Image size 1240x1240; wide-field contact fundus photograph of an infant — 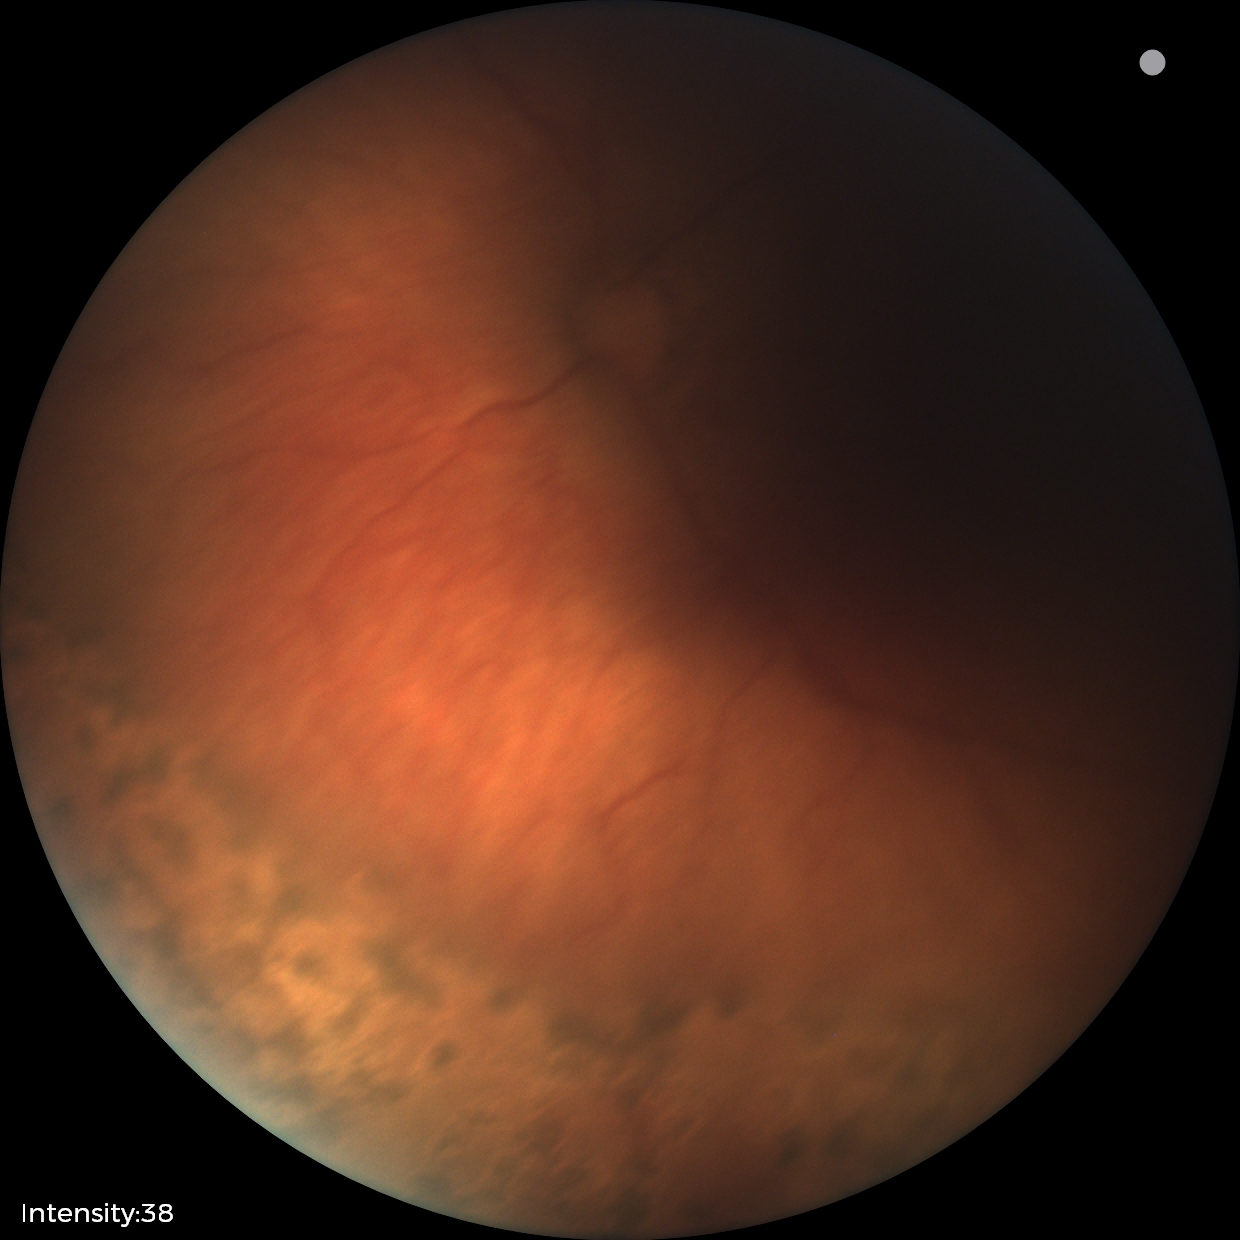
Q: What was the screening finding?
A: status post retinopathy of prematurity (ROP) — retinal appearance after treated retinopathy of prematurity
Q: What is the plus-form classification?
A: no plus disease